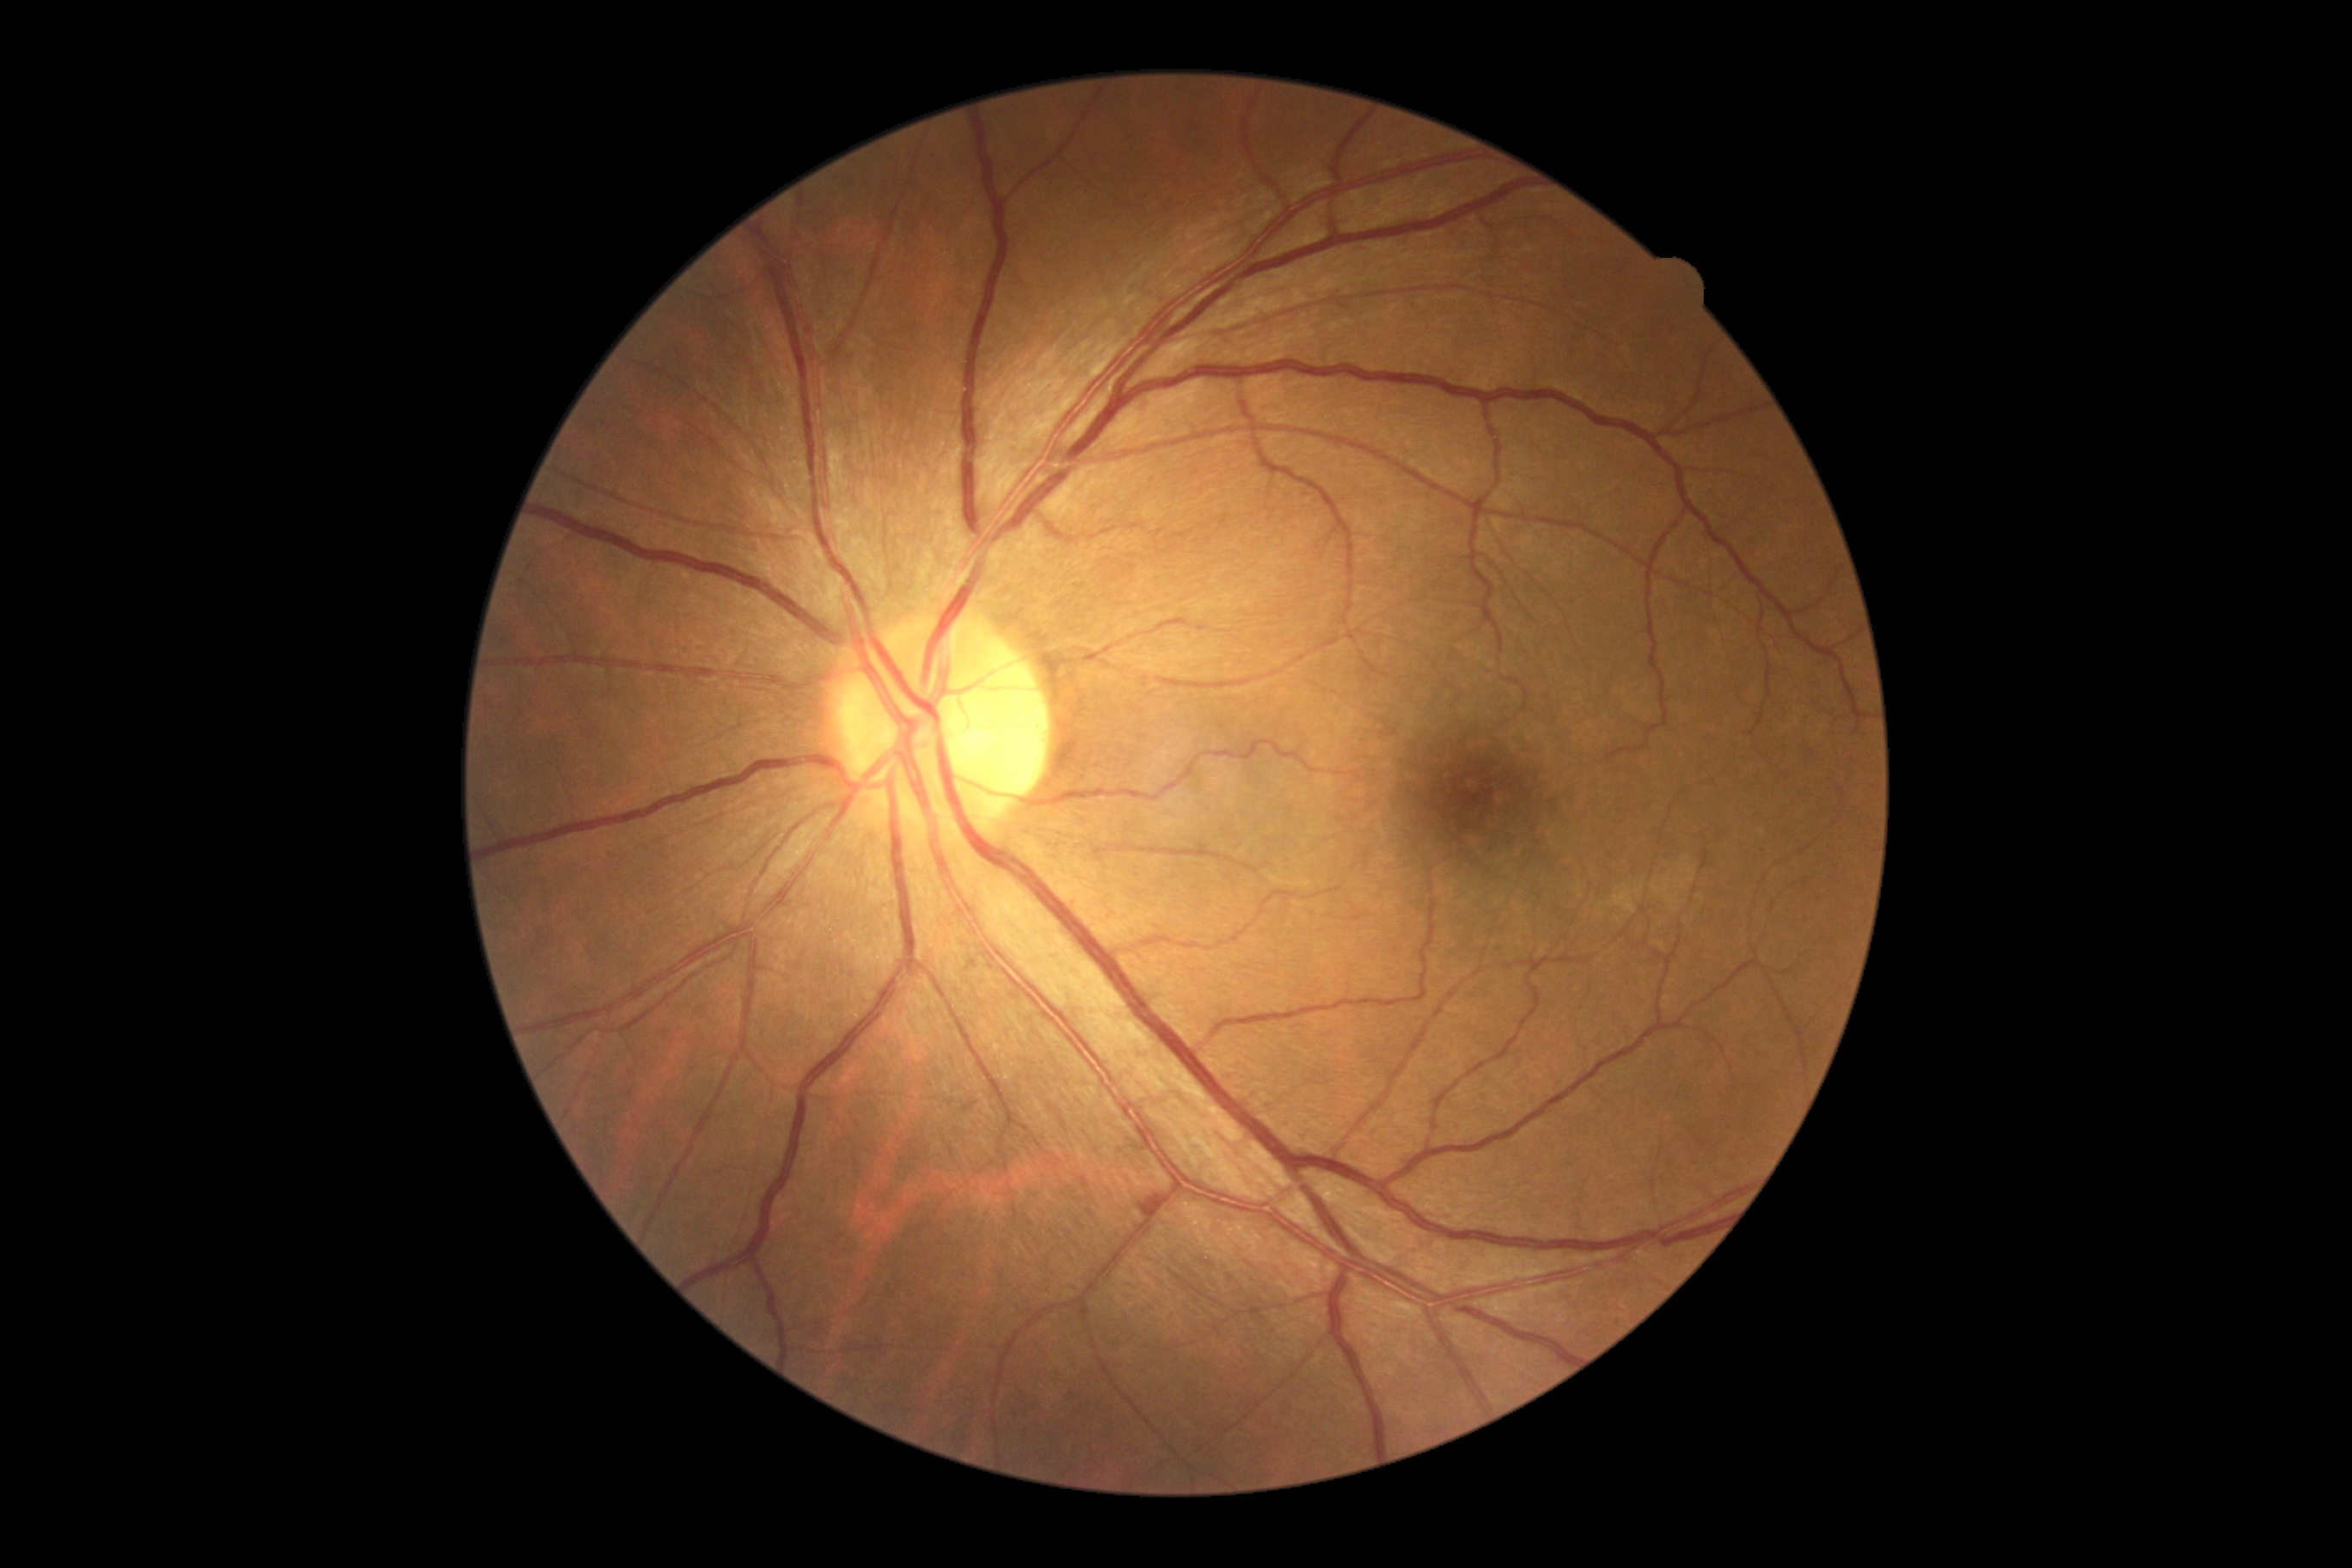
DR severity is 2/4.